45 degree fundus photograph. 848 x 848 pixels. NIDEK AFC-230 fundus camera. Without pupil dilation.
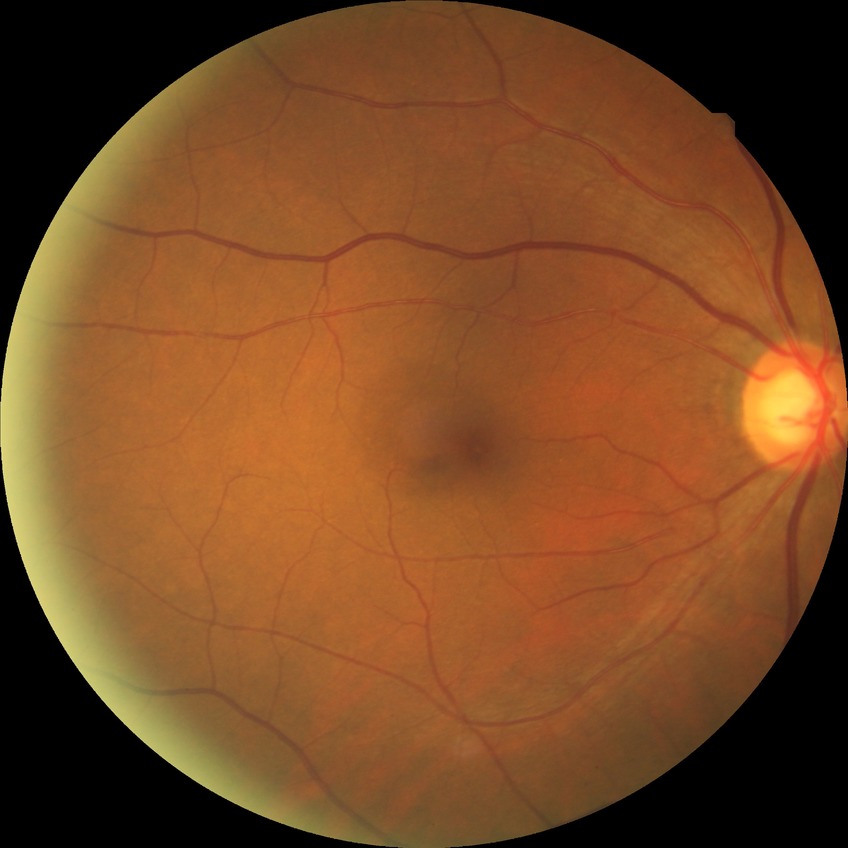

diabetic retinopathy (DR): NDR (no diabetic retinopathy)